Acquired with a Topcon TRC-NW400 — 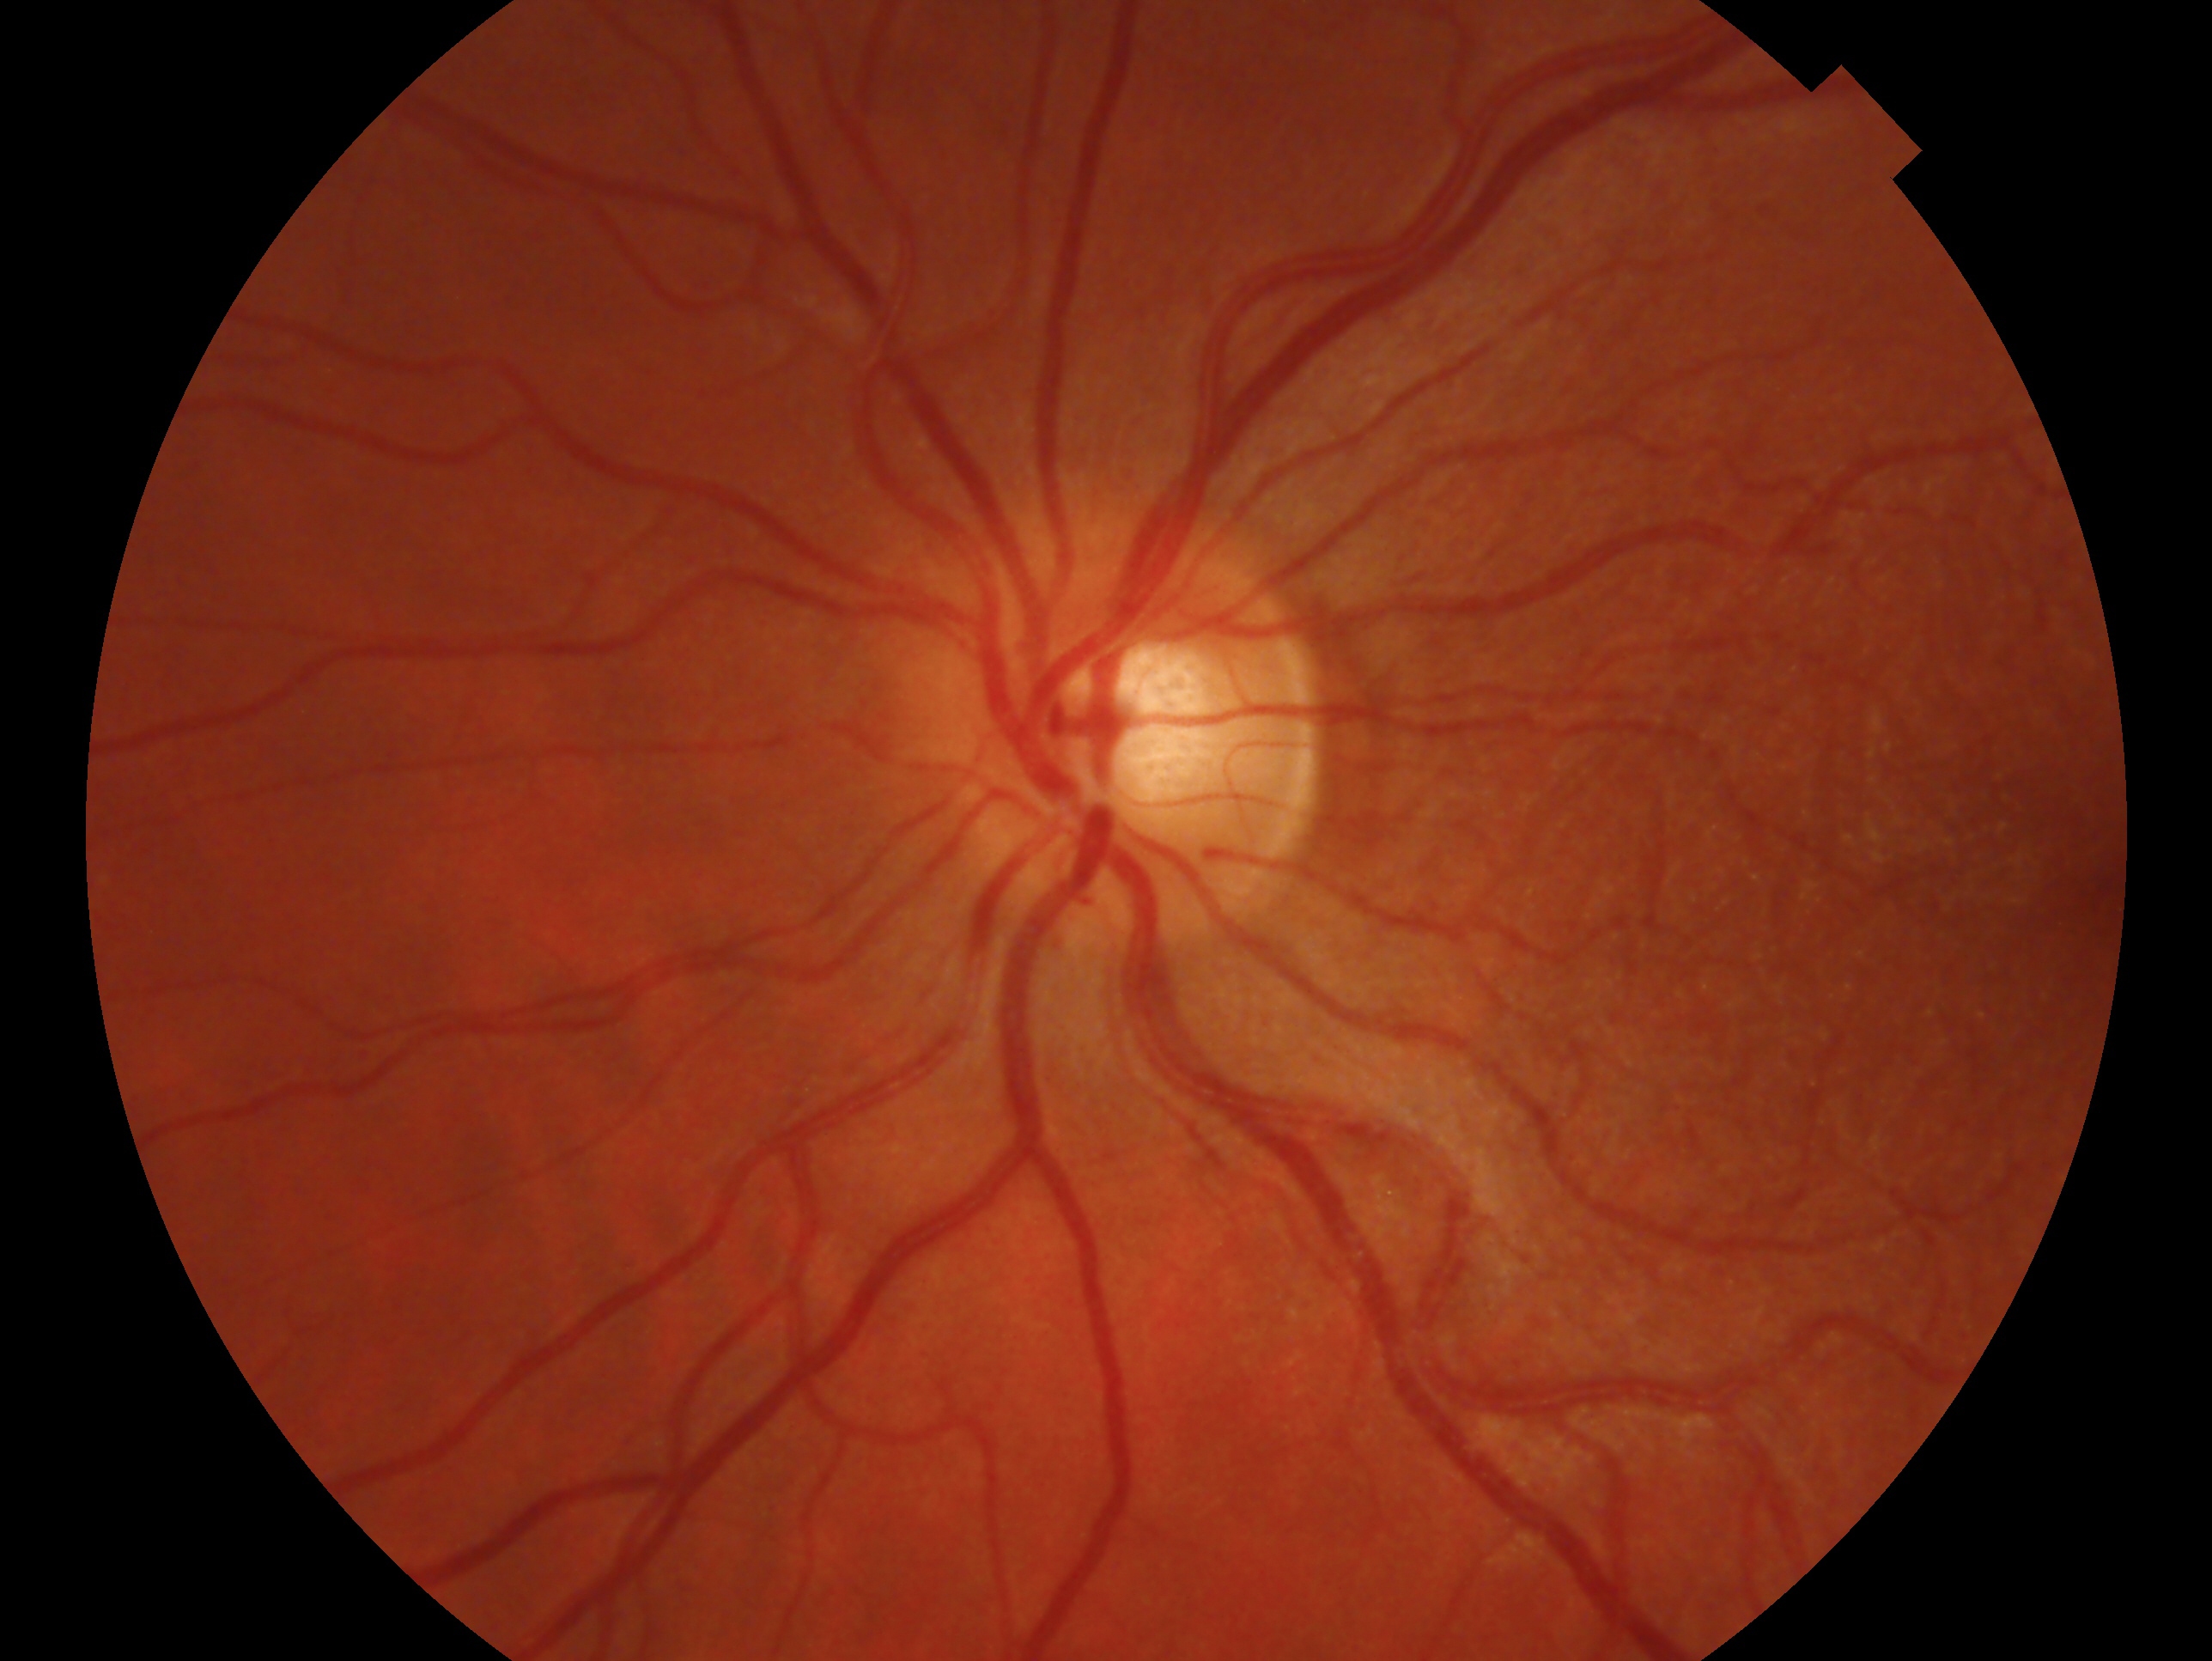 Diagnosis: no evidence of glaucoma.
Eye: OS.